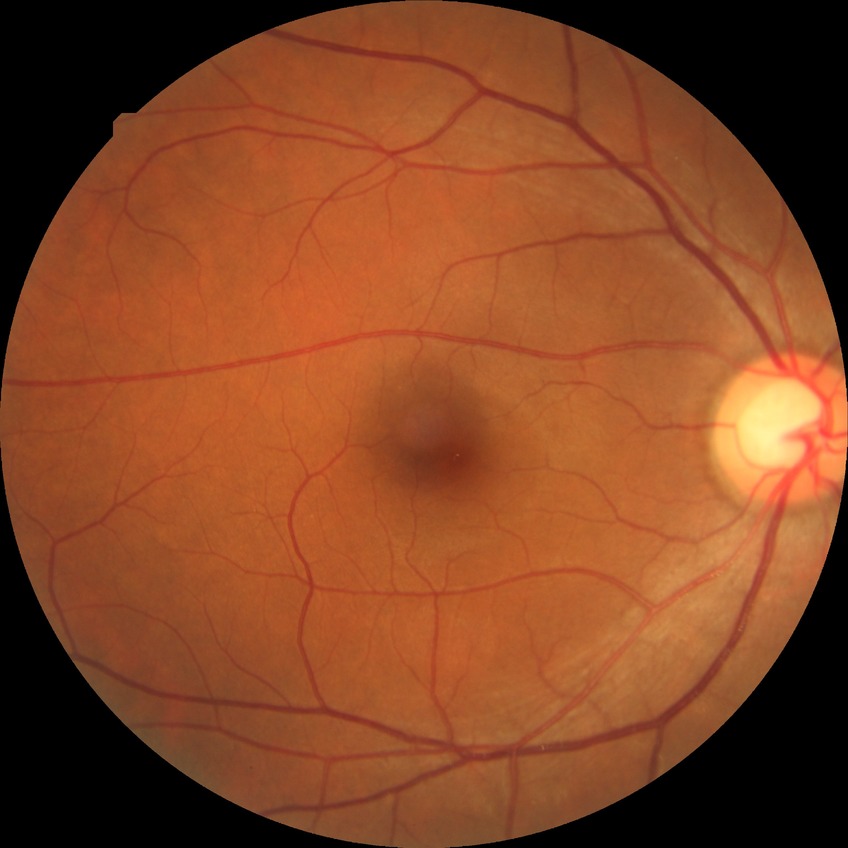

diabetic retinopathy (DR) = no diabetic retinopathy (NDR).